45° FOV; 1932x1923px — 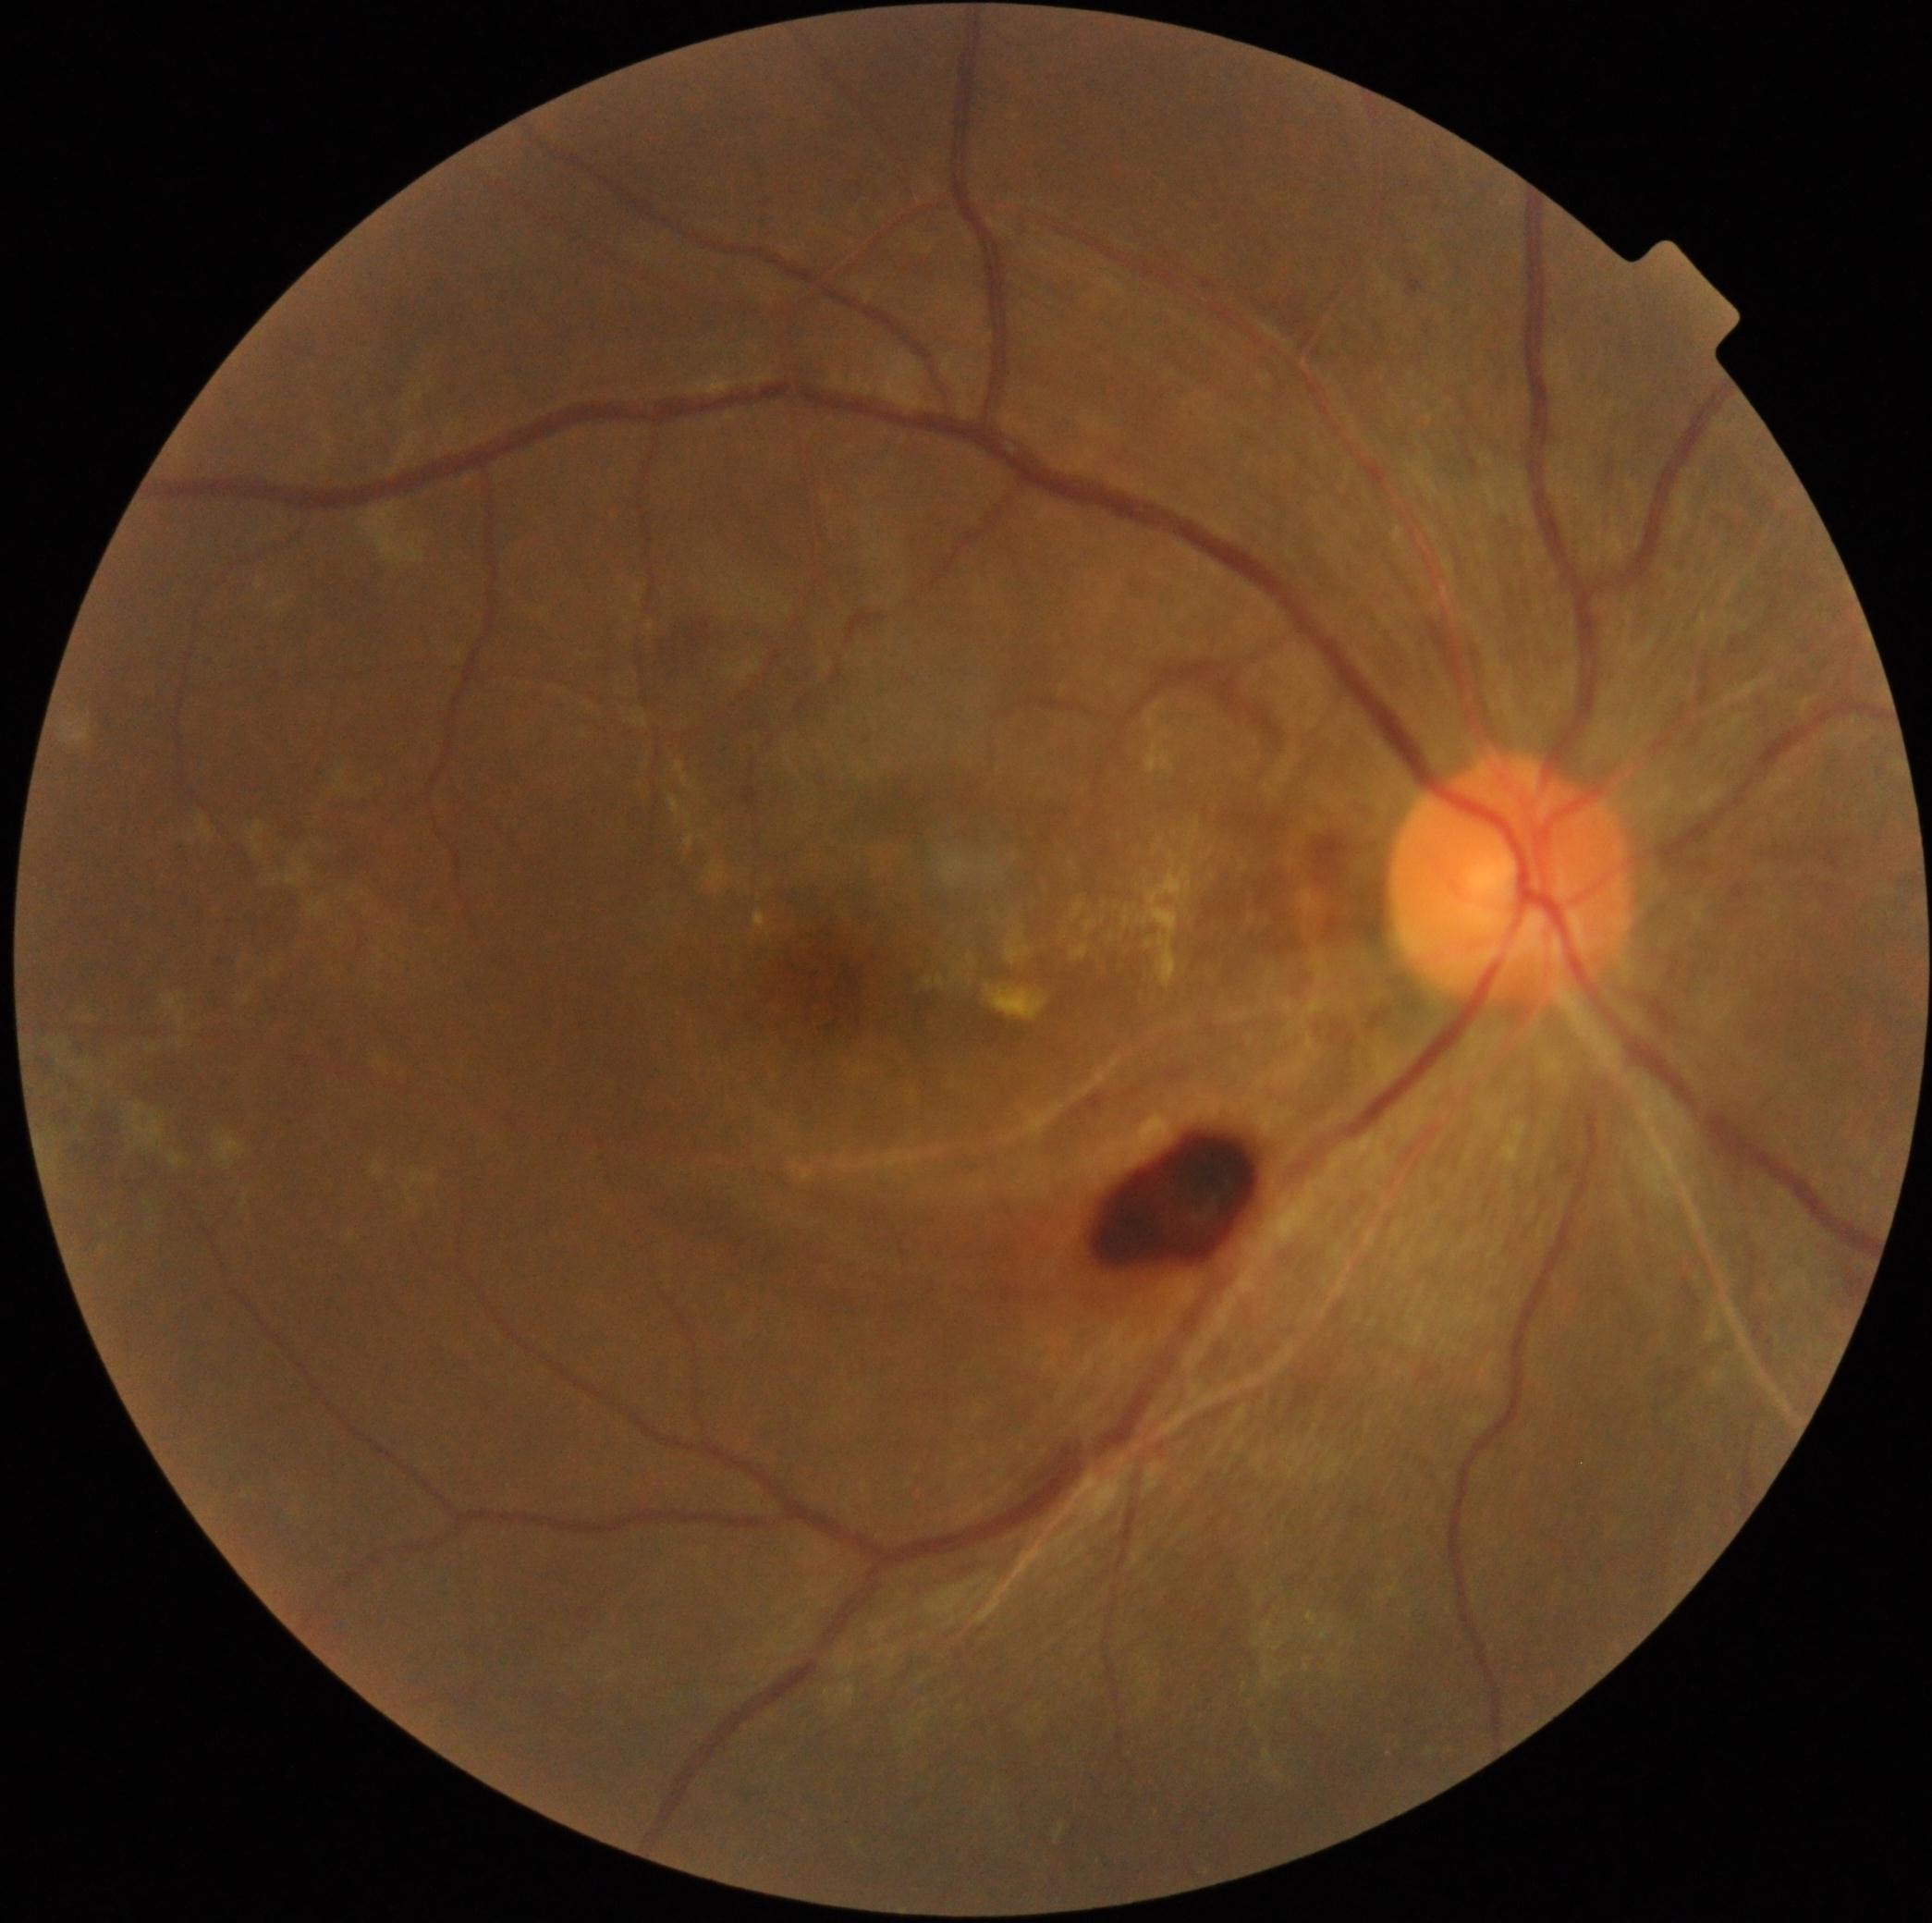

dr_grade: moderate NPDR (2)